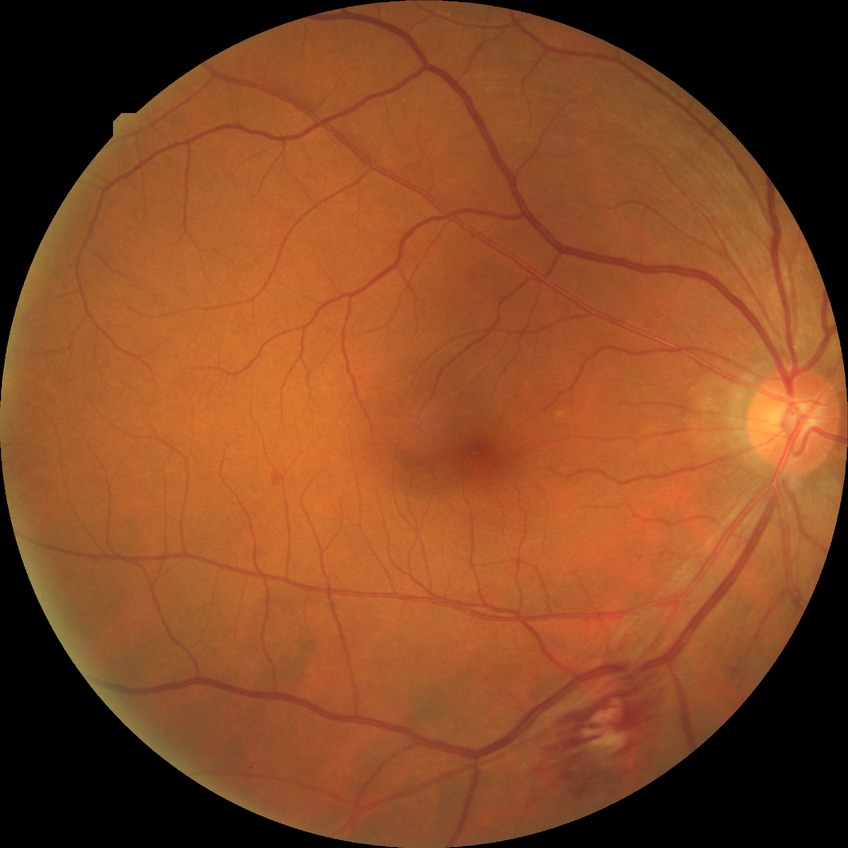

proliferative_class: non-proliferative diabetic retinopathy
davis_grade: simple diabetic retinopathy